Wide-field fundus photograph from neonatal ROP screening. Acquired on the Clarity RetCam 3. Image size 640x480 — 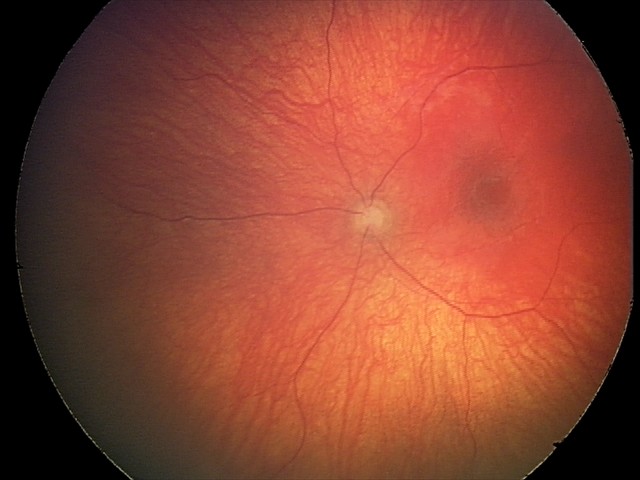

Diagnosis from this screening exam: optic nerve hypoplasia.